Retinal fundus photograph, 848x848px.
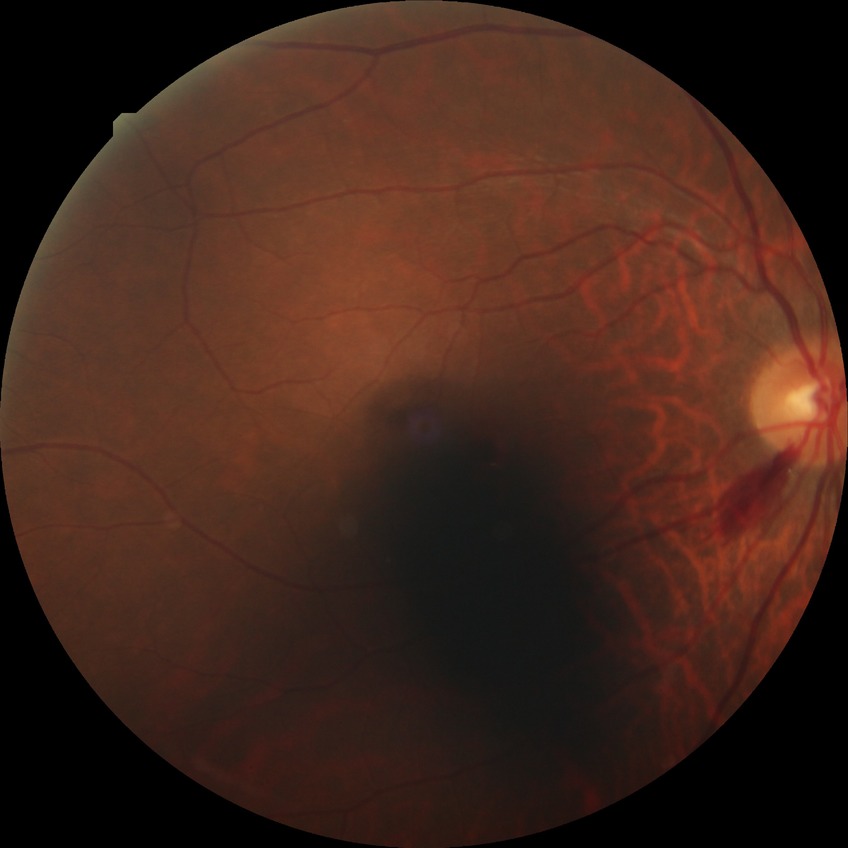
Diabetic retinopathy (DR): NDR (no diabetic retinopathy).